1240x1240px; wide-field contact fundus photograph of an infant:
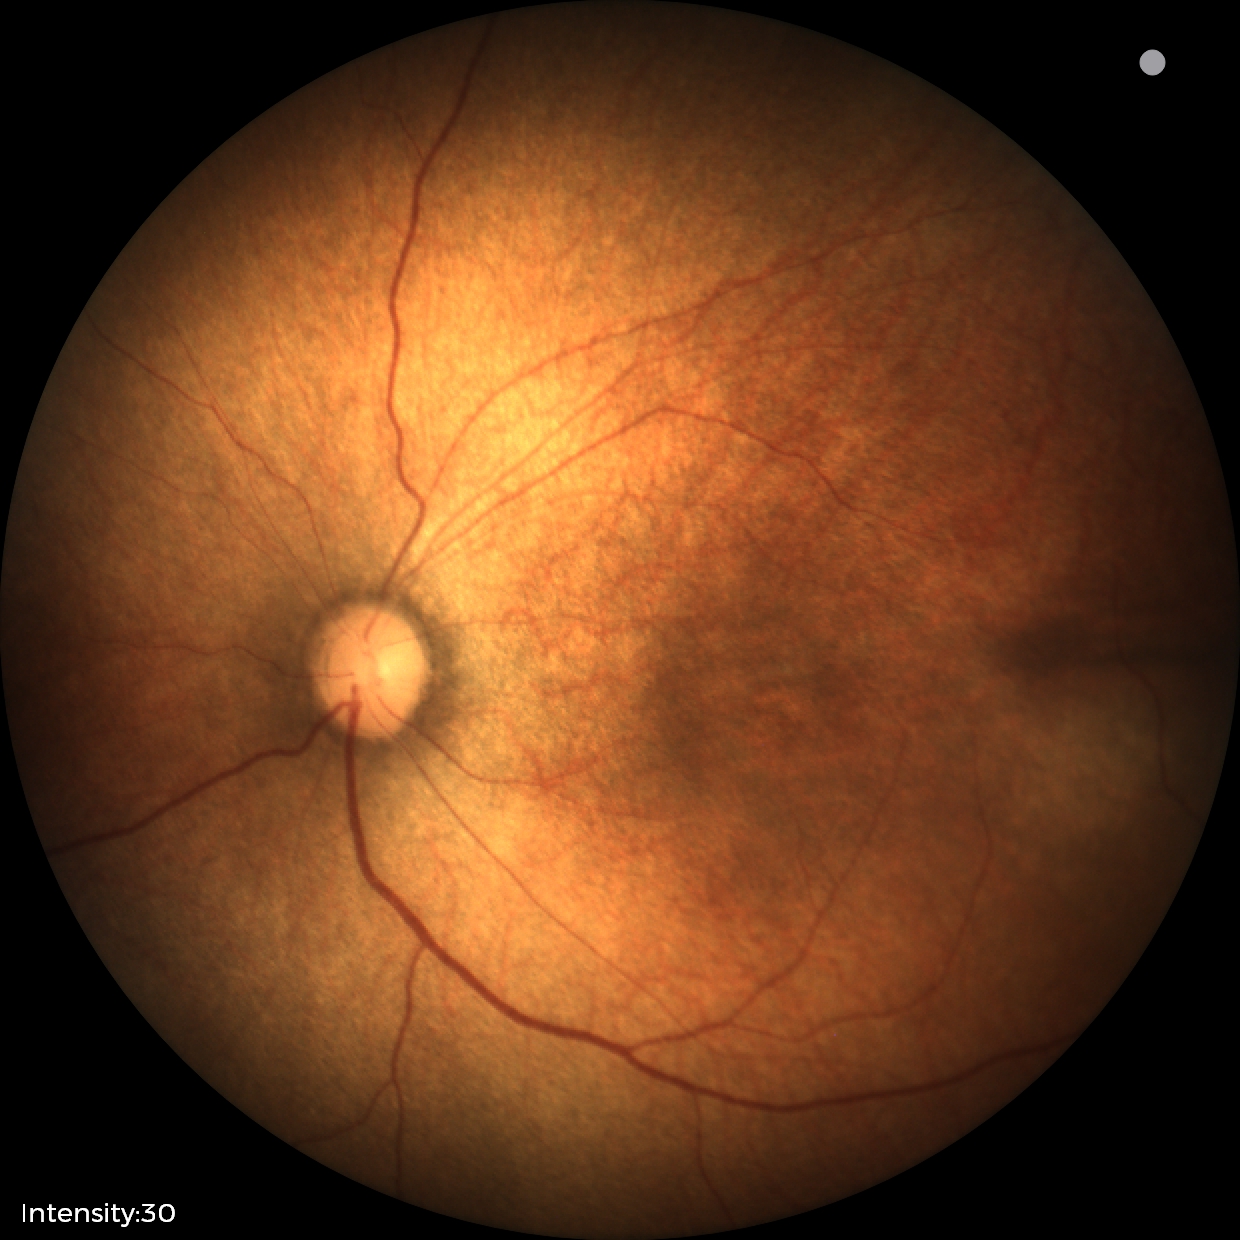

Diagnosis: physiological appearance.